45-degree field of view.
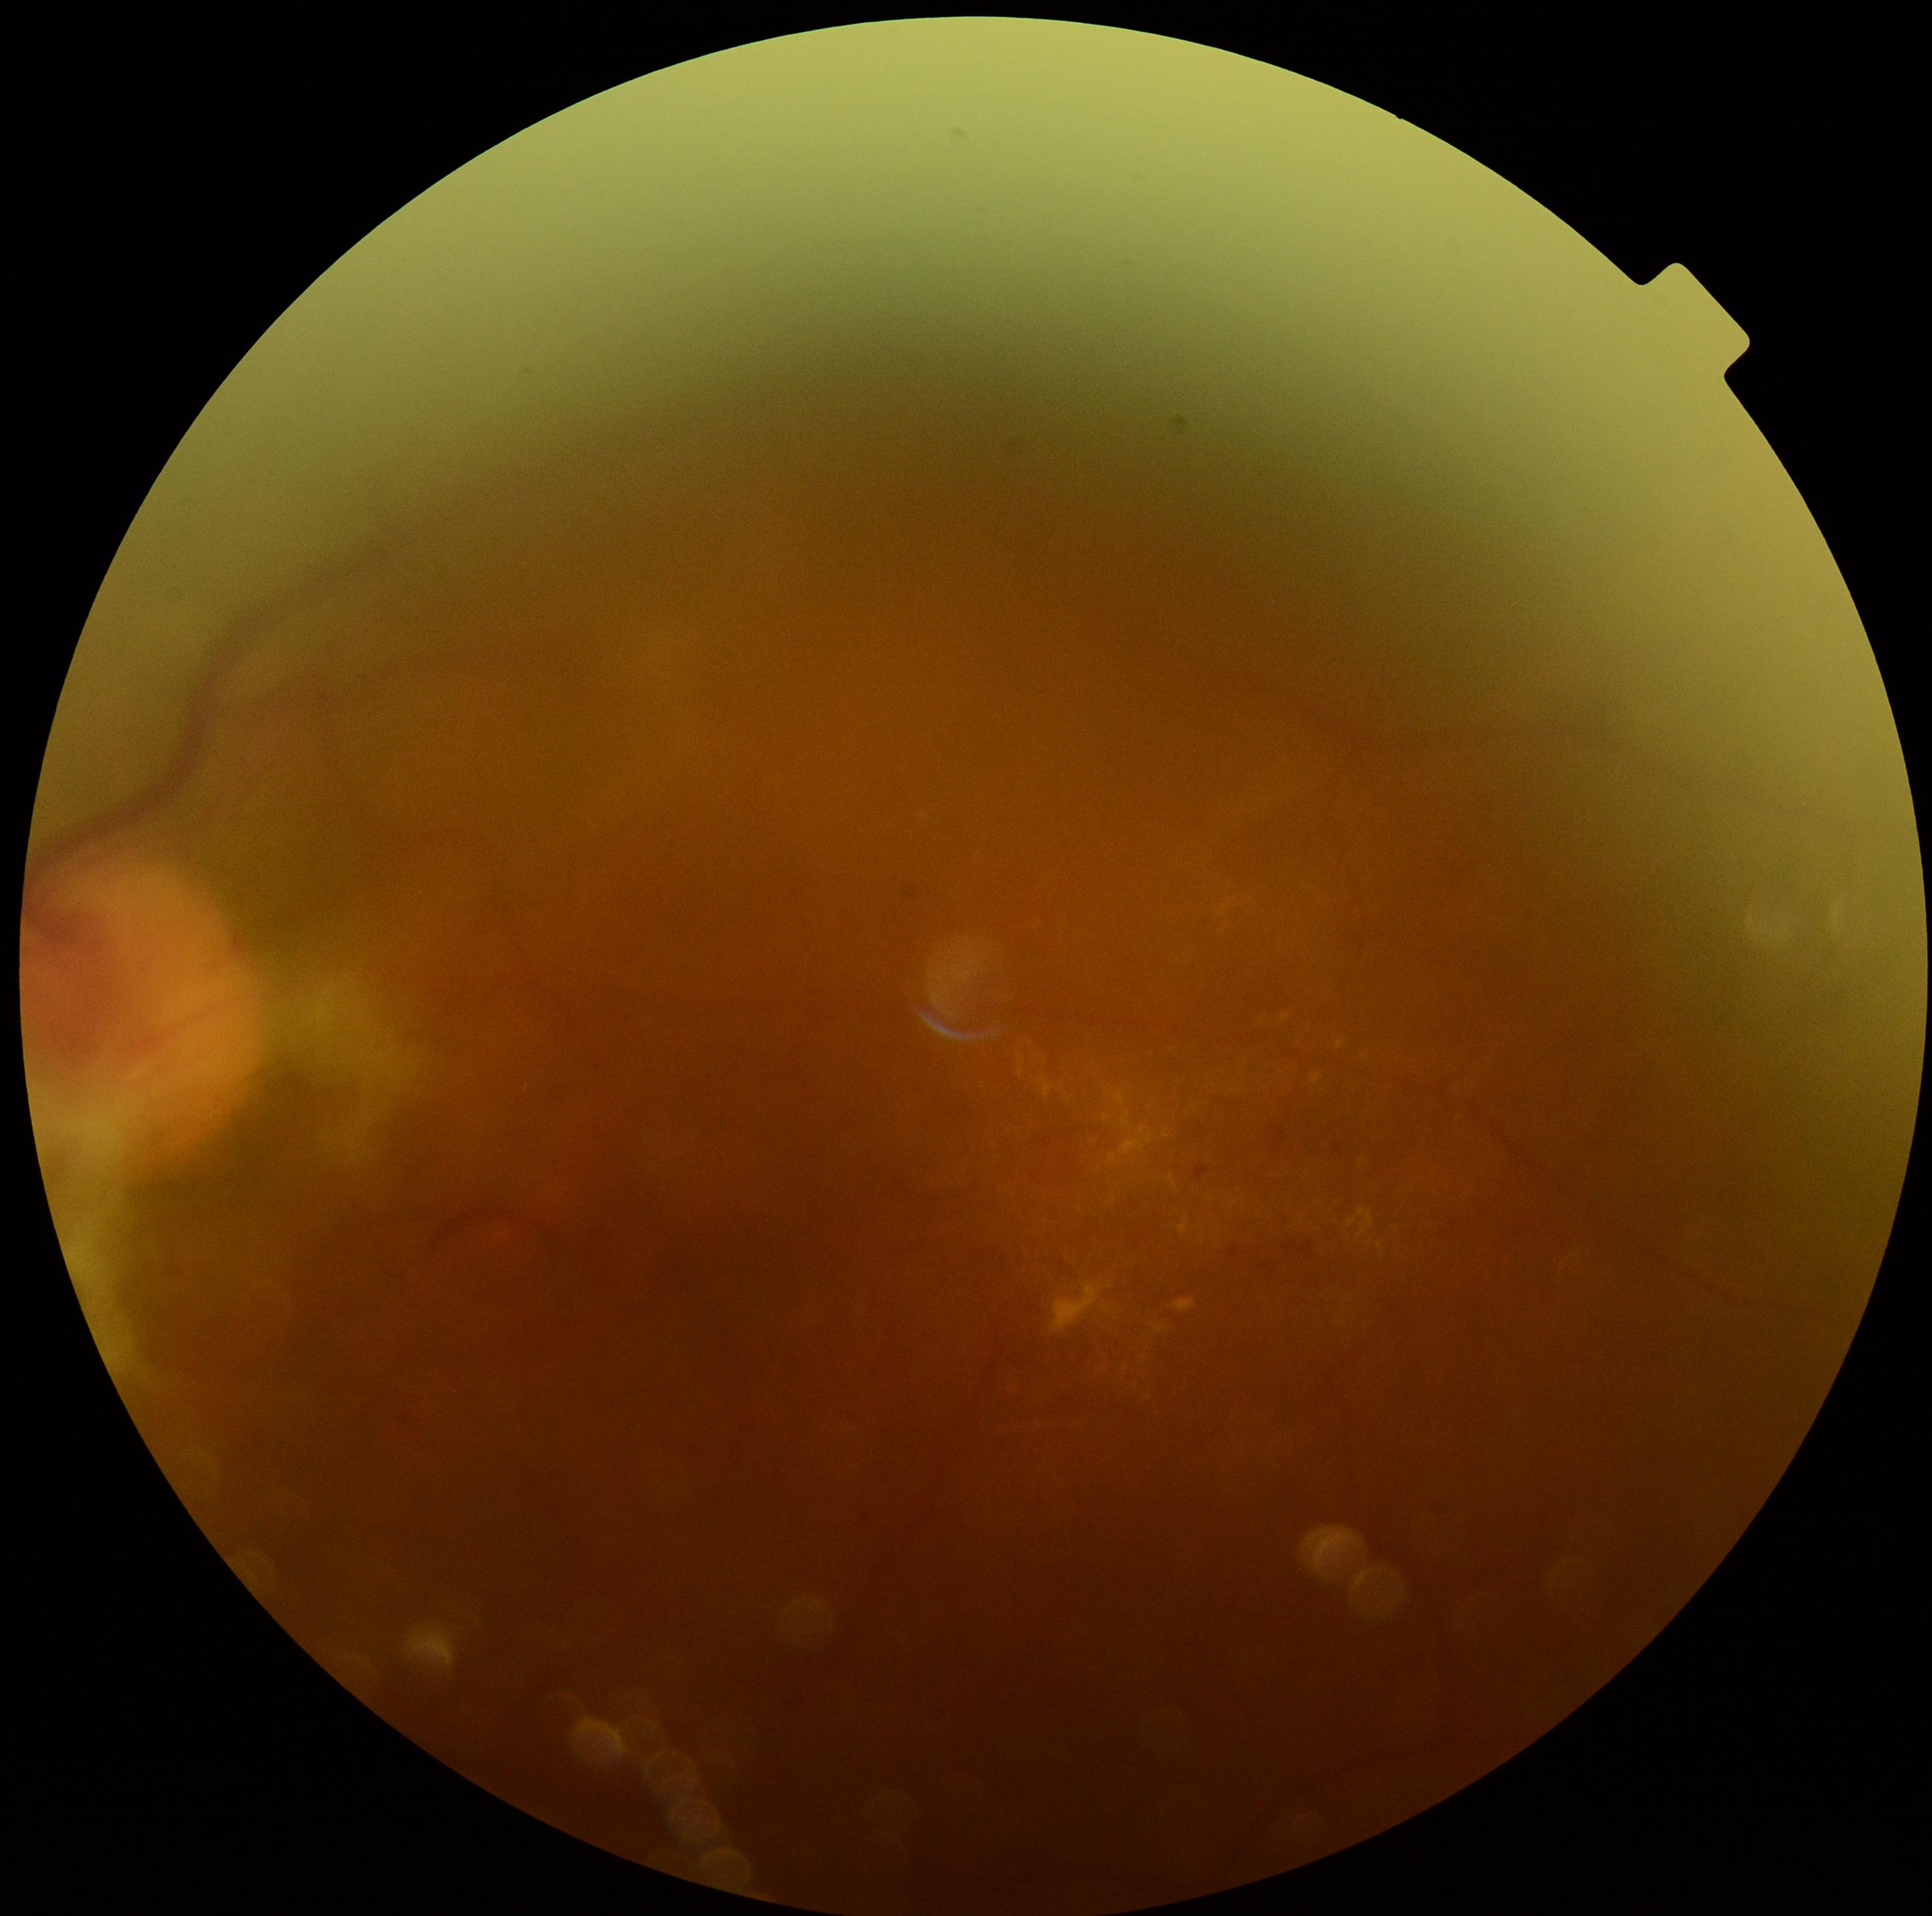 Retinopathy: 4/4 — neovascularization and/or vitreous/pre-retinal hemorrhage.